CFP; 1536x1152; 45° FOV: 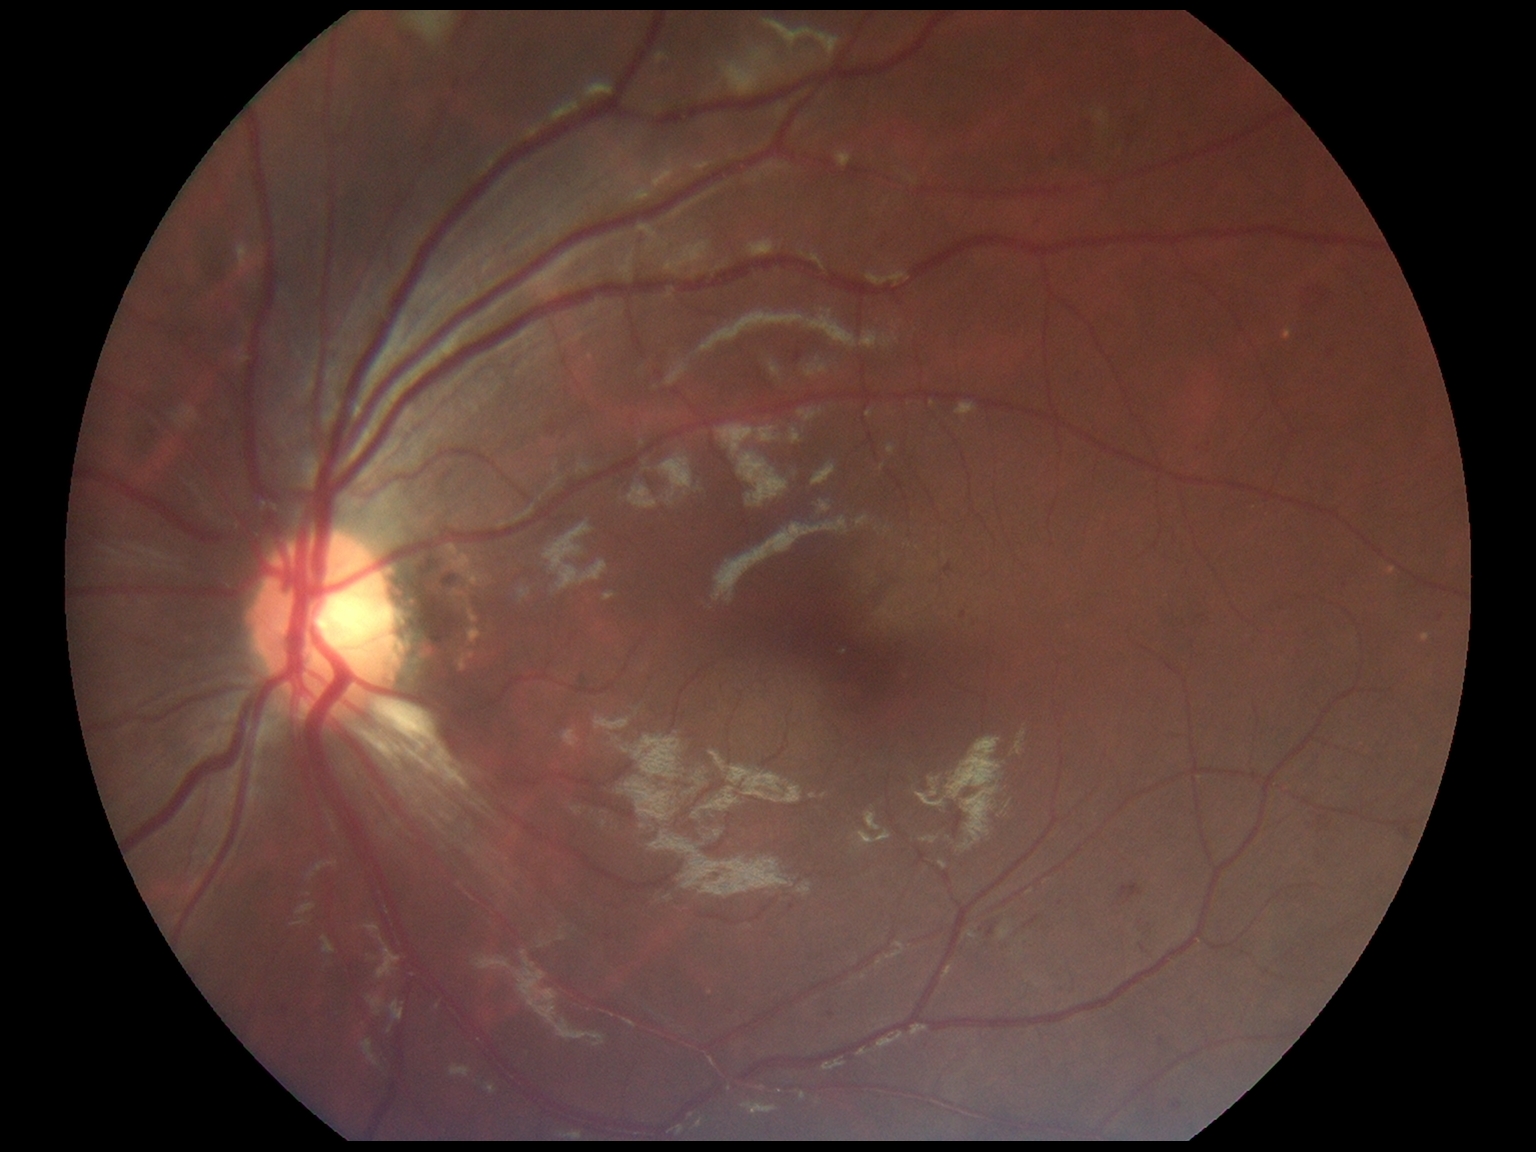
dr_category: non-proliferative diabetic retinopathy
dr_grade: 2